NIDEK AFC-230 fundus camera, 848x848px, nonmydriatic
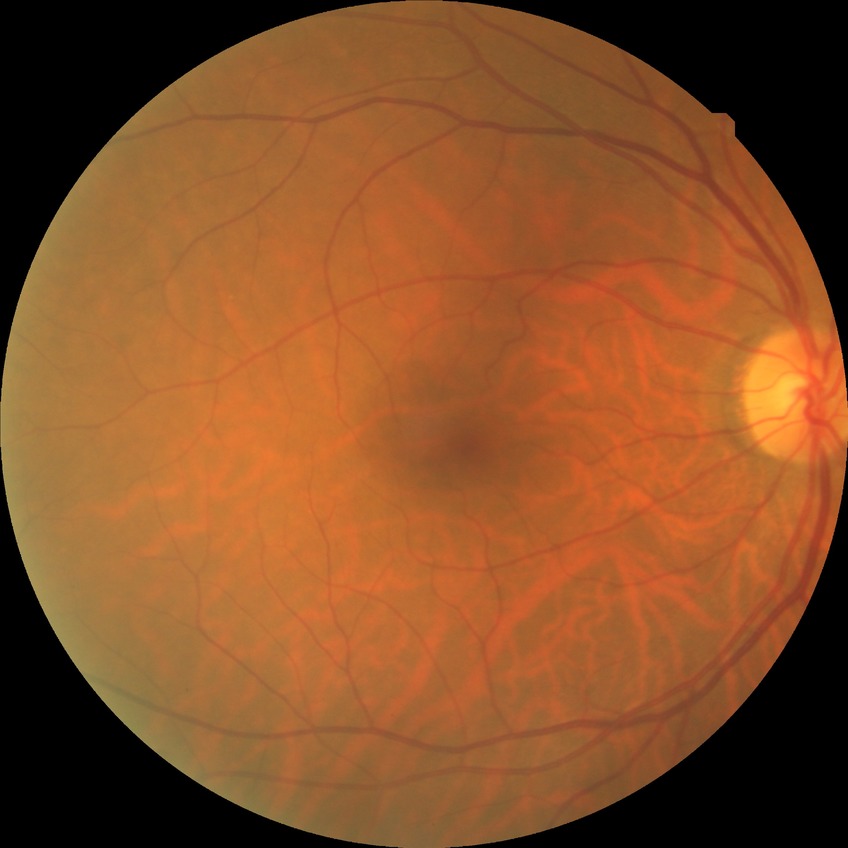 {
  "davis_grade": "no diabetic retinopathy"
}